Color fundus image · 45-degree field of view · 2212x1659 — 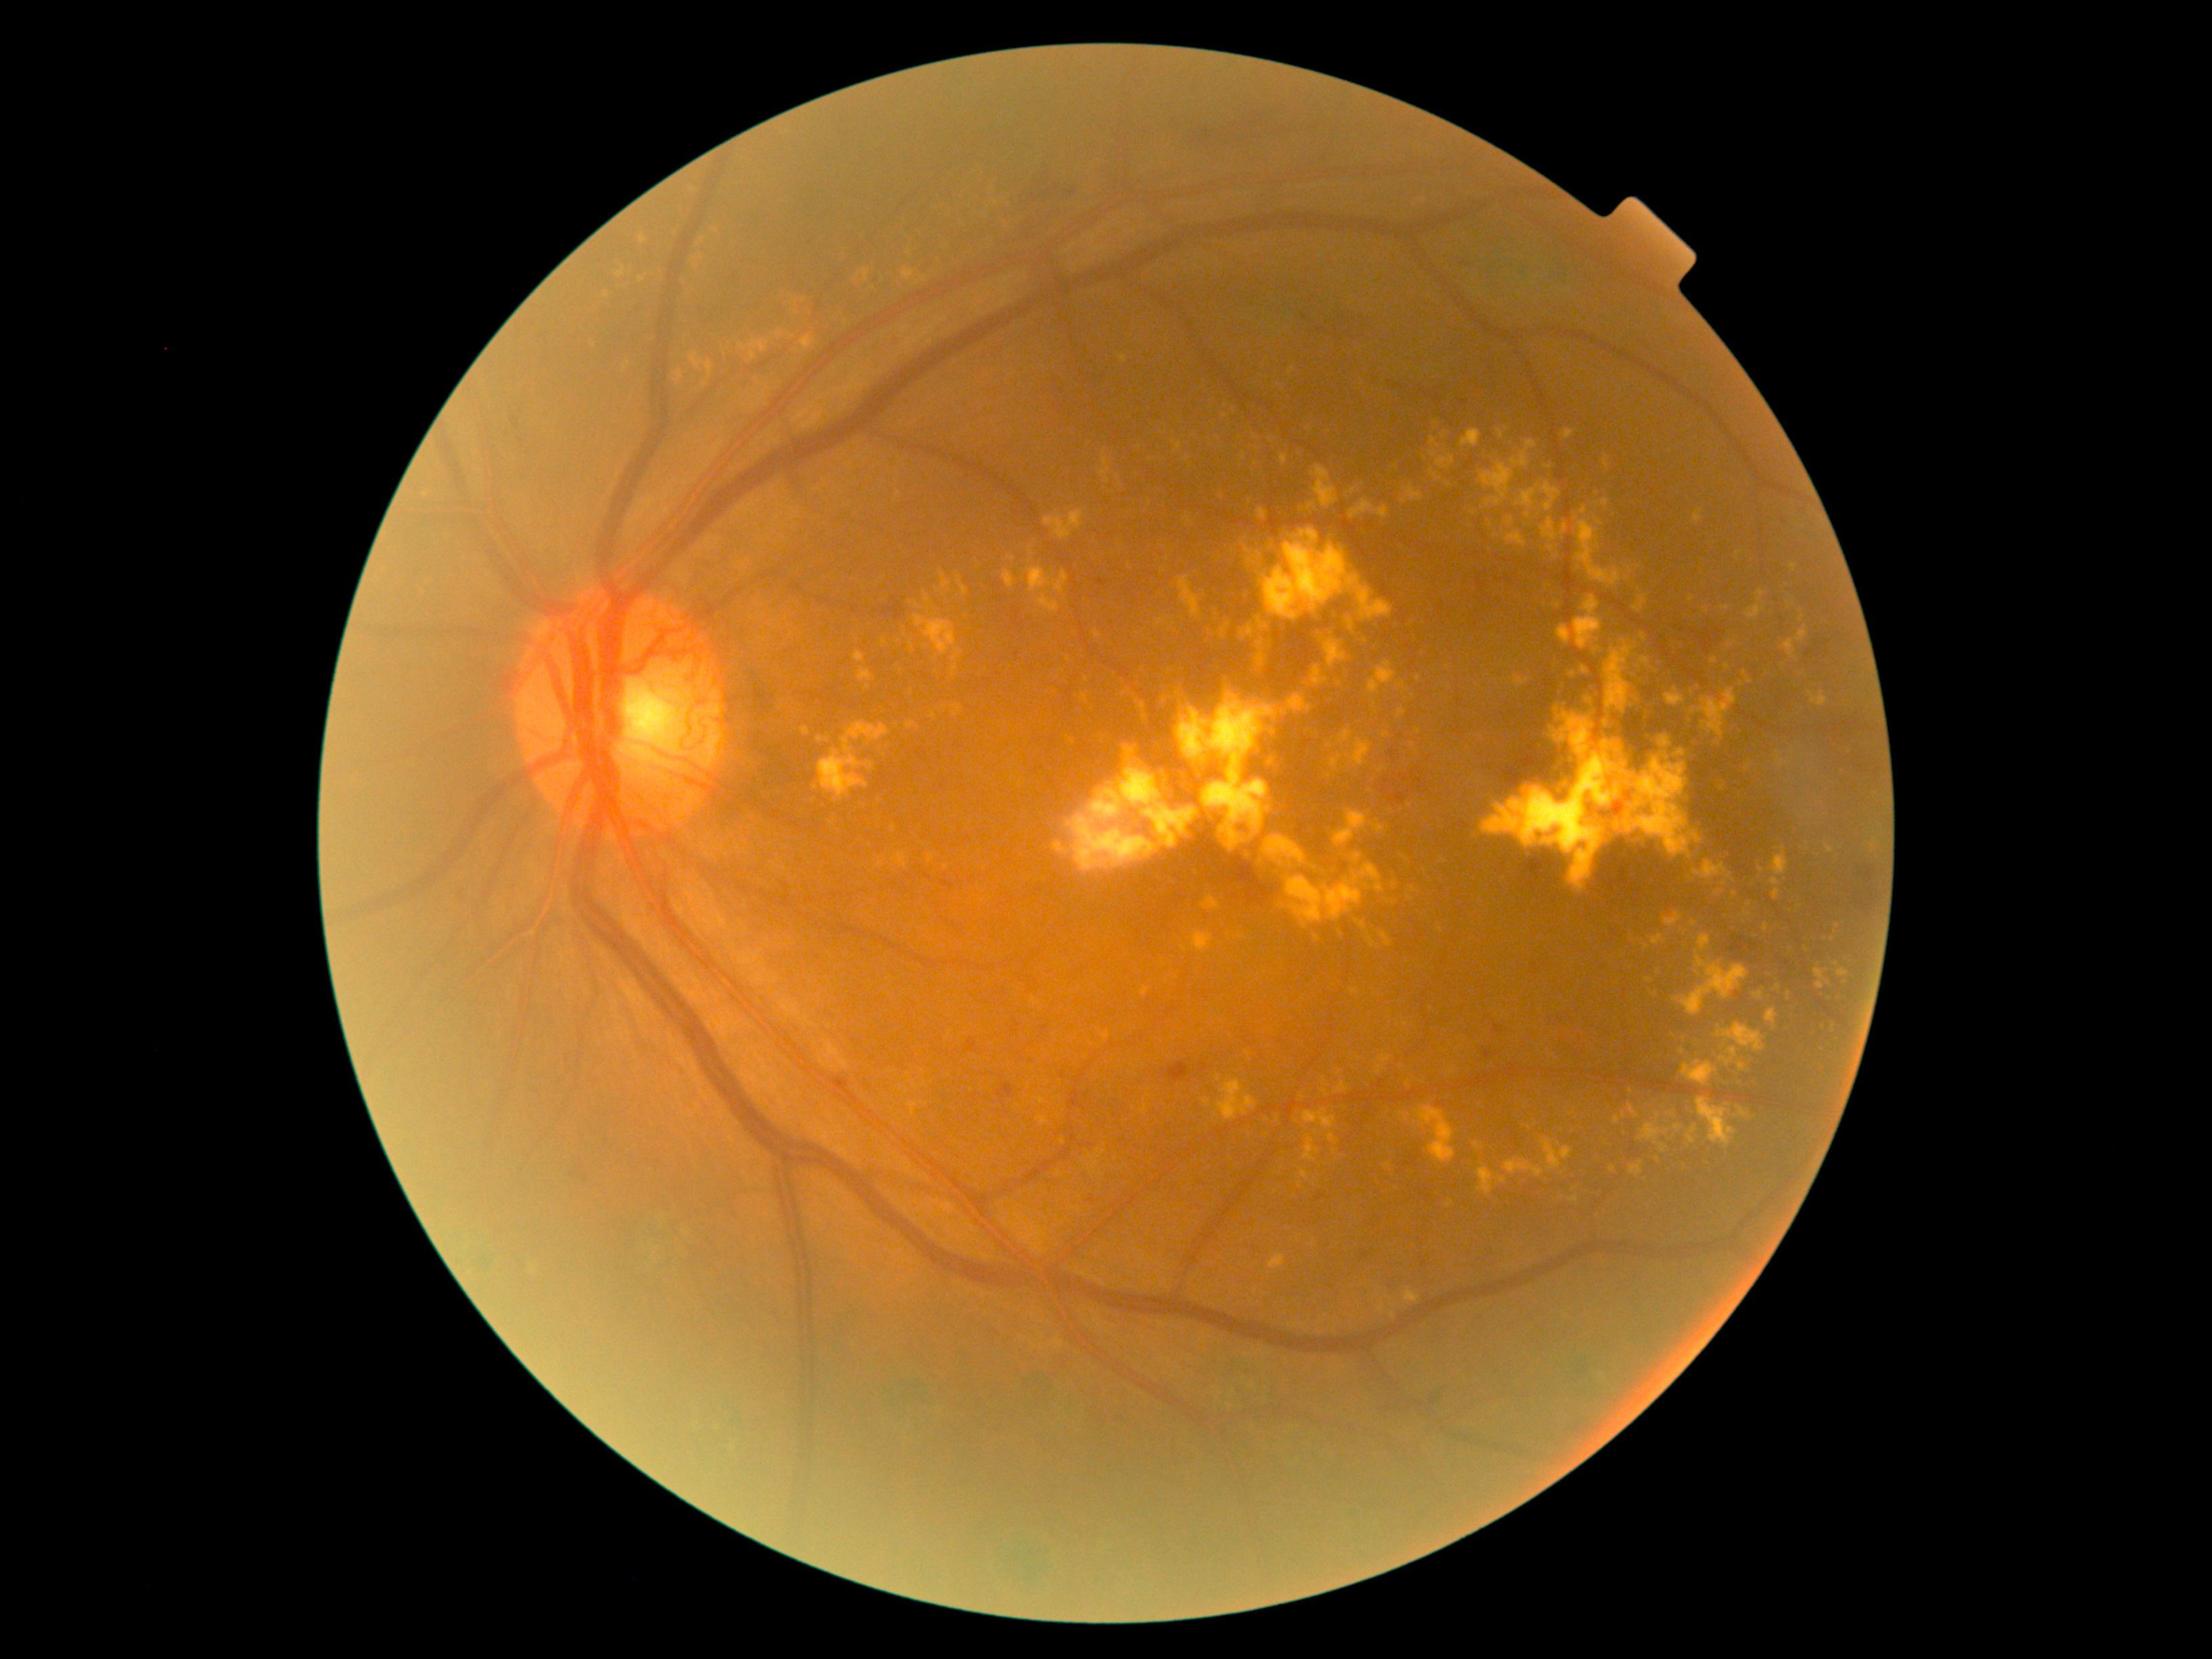

{"partial":true,"dr_grade":4,"dr_grade_name":"PDR","lesions":{"he":[[1399,775,1409,781],[1021,176,1081,209],[1852,887,1877,905],[1695,631,1730,655],[1462,250,1477,265],[1454,398,1470,409],[1767,959,1780,967],[453,888,466,909],[1383,779,1391,796],[1732,936,1750,960],[573,1162,583,1181]],"he_small_centers":[[1395,783],[1788,965]],"ex":[[1600,499,1608,508],[1718,1023,1764,1054],[1176,687,1276,852],[1694,510,1703,524],[1554,658,1563,669],[1164,794,1172,803],[903,268,916,281],[1493,529,1504,533],[1745,590,1765,620],[1698,935,1711,952],[803,727,810,735],[1764,924,1768,932],[1462,430,1482,447]],"ex_small_centers":[[1838,926],[1207,1103],[1667,1133],[1395,885],[884,644],[1097,634],[1307,429]]}}